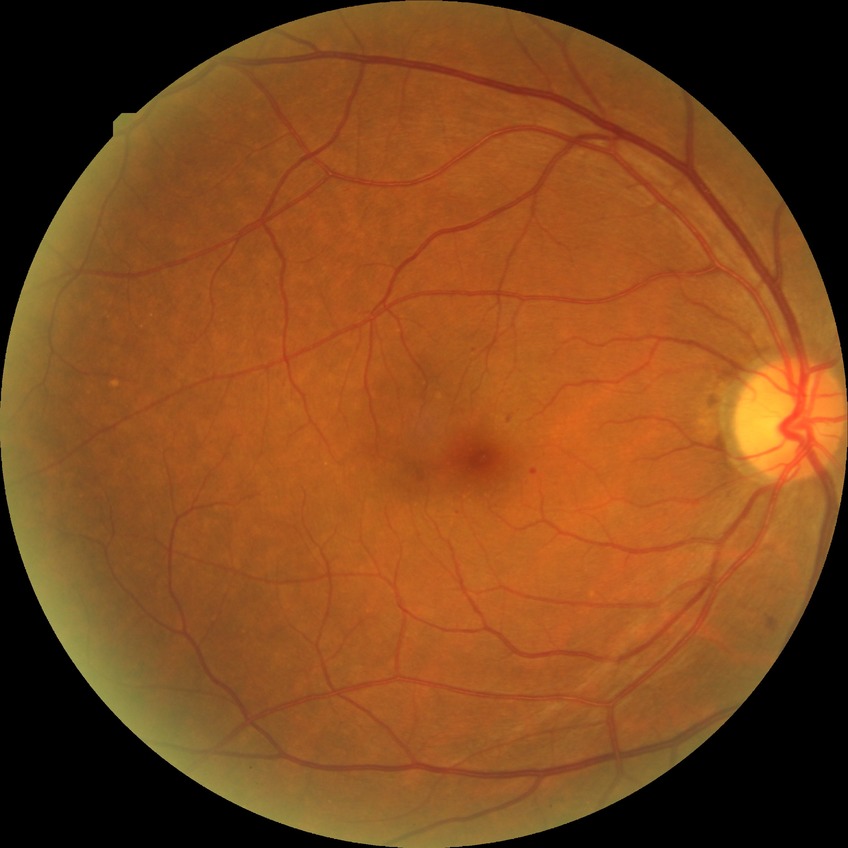
{
  "davis_grade": "SDR"
}